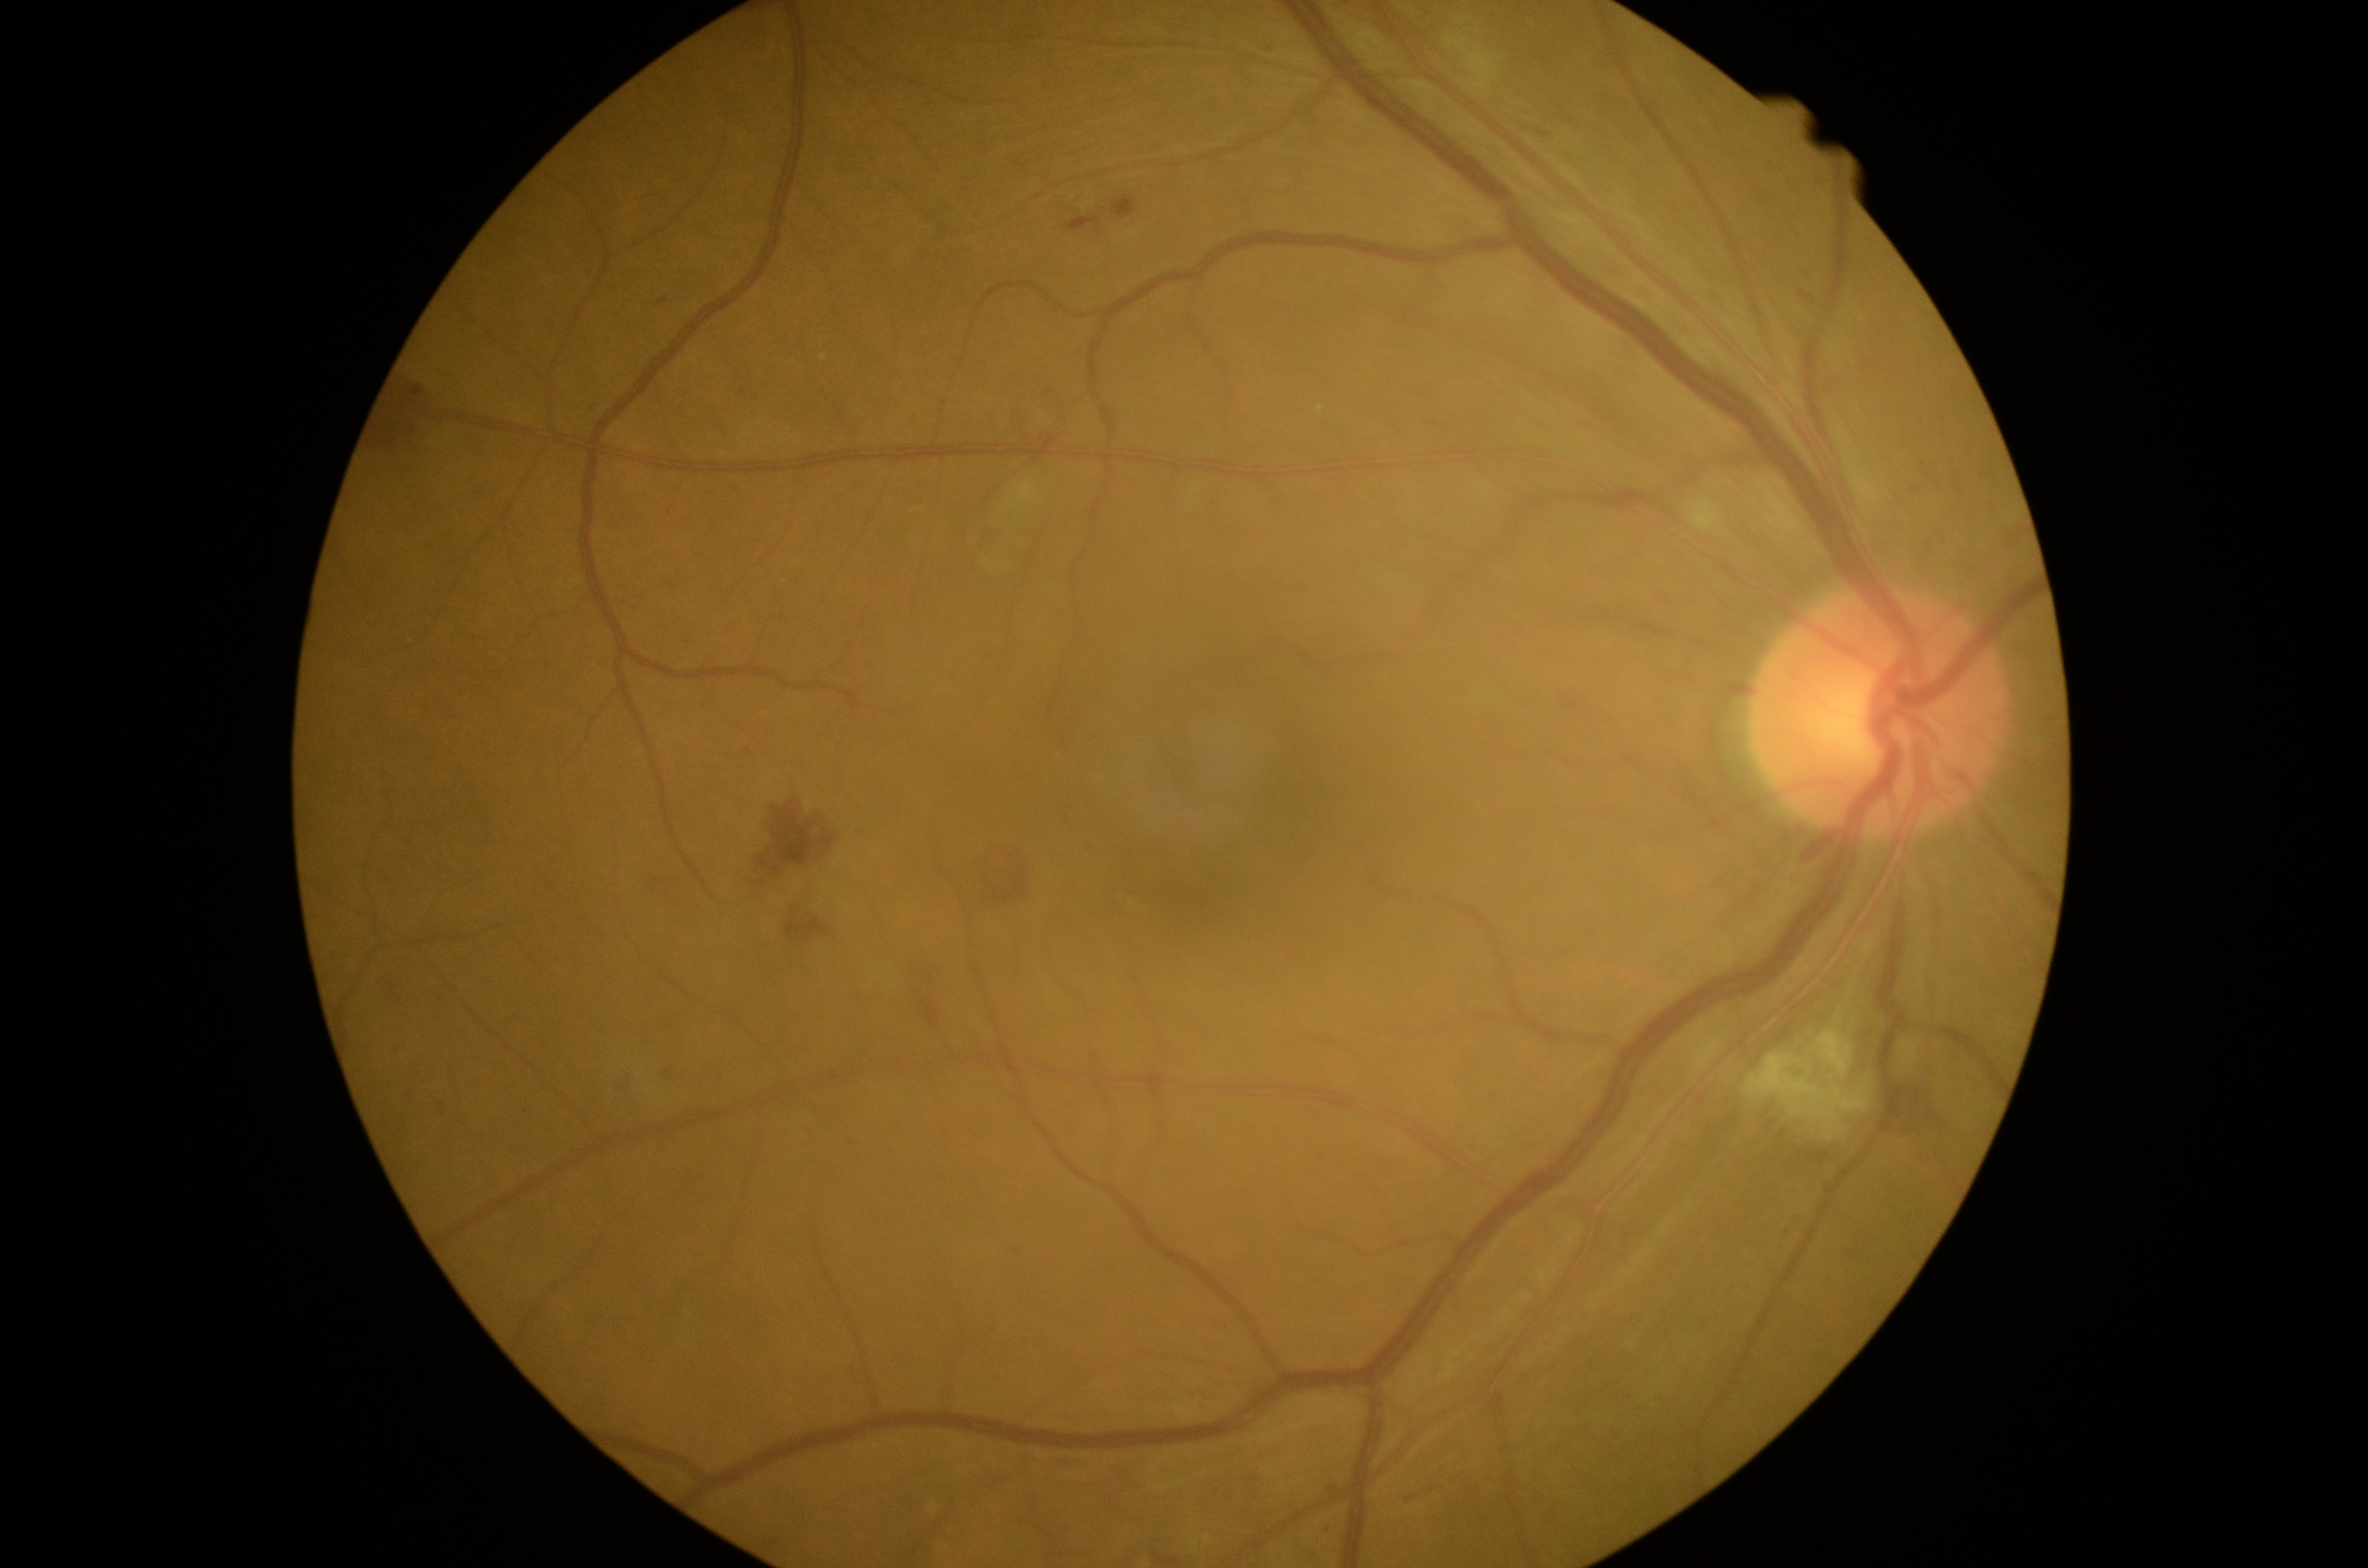

DR stage: 2
A subset of detected lesions:
HEs = (796, 891, 815, 917); (757, 800, 836, 877); (1013, 411, 1028, 434); (982, 843, 1030, 914); (1806, 834, 1839, 862); (1066, 218, 1103, 233); (787, 917, 832, 943); (1887, 1079, 1945, 1138); (375, 373, 439, 439); (912, 961, 947, 1015); (613, 1075, 637, 1092); (1728, 682, 1752, 697); (380, 980, 396, 997); (1051, 1456, 1086, 1470)
EXs = none detected
MAs (more not shown) = (1801, 291, 1816, 304); (665, 1070, 674, 1077); (407, 1088, 413, 1099); (660, 300, 669, 306); (1114, 199, 1137, 220); (1013, 1251, 1022, 1260); (444, 1105, 450, 1114); (1657, 592, 1670, 604); (1079, 843, 1088, 851); (1535, 132, 1545, 138); (1264, 46, 1279, 55)
Small MAs near (1438,426); (1411,1499); (743,393); (1068,814); (753,755); (1326,1529); (552,888)
SEs = (1690, 499, 1722, 533); (1743, 1028, 1872, 1141)